Camera: NIDEK AFC-230. 848x848px. FOV: 45 degrees. Retinal fundus photograph. Nonmydriatic fundus photograph
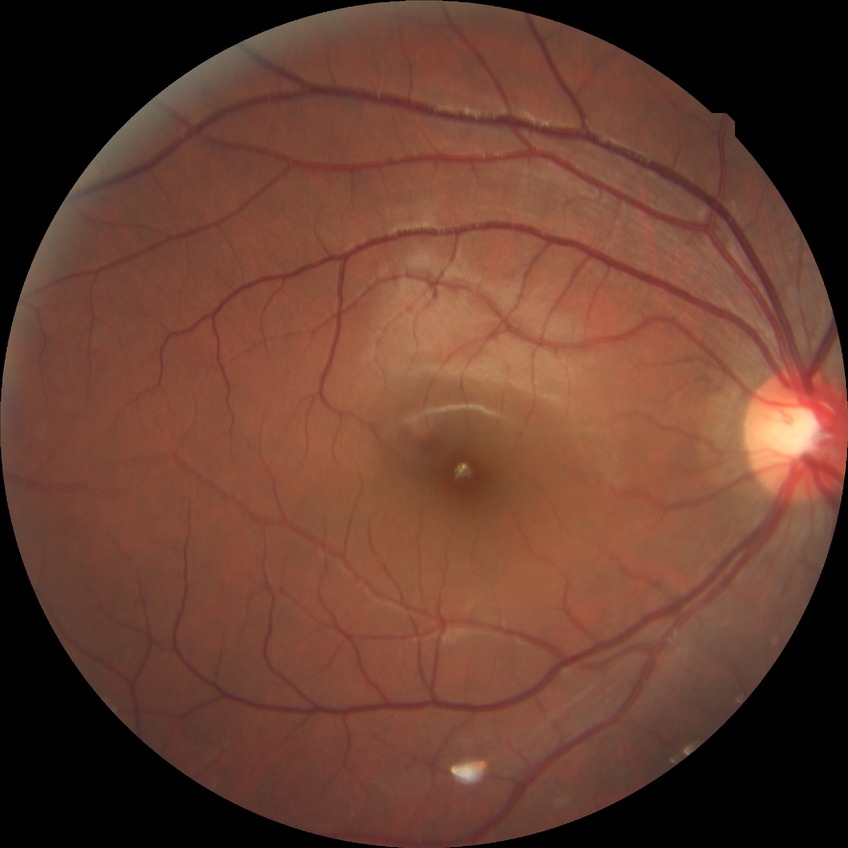
Annotations:
• DR impression: no apparent DR
• modified Davis grade: NDR